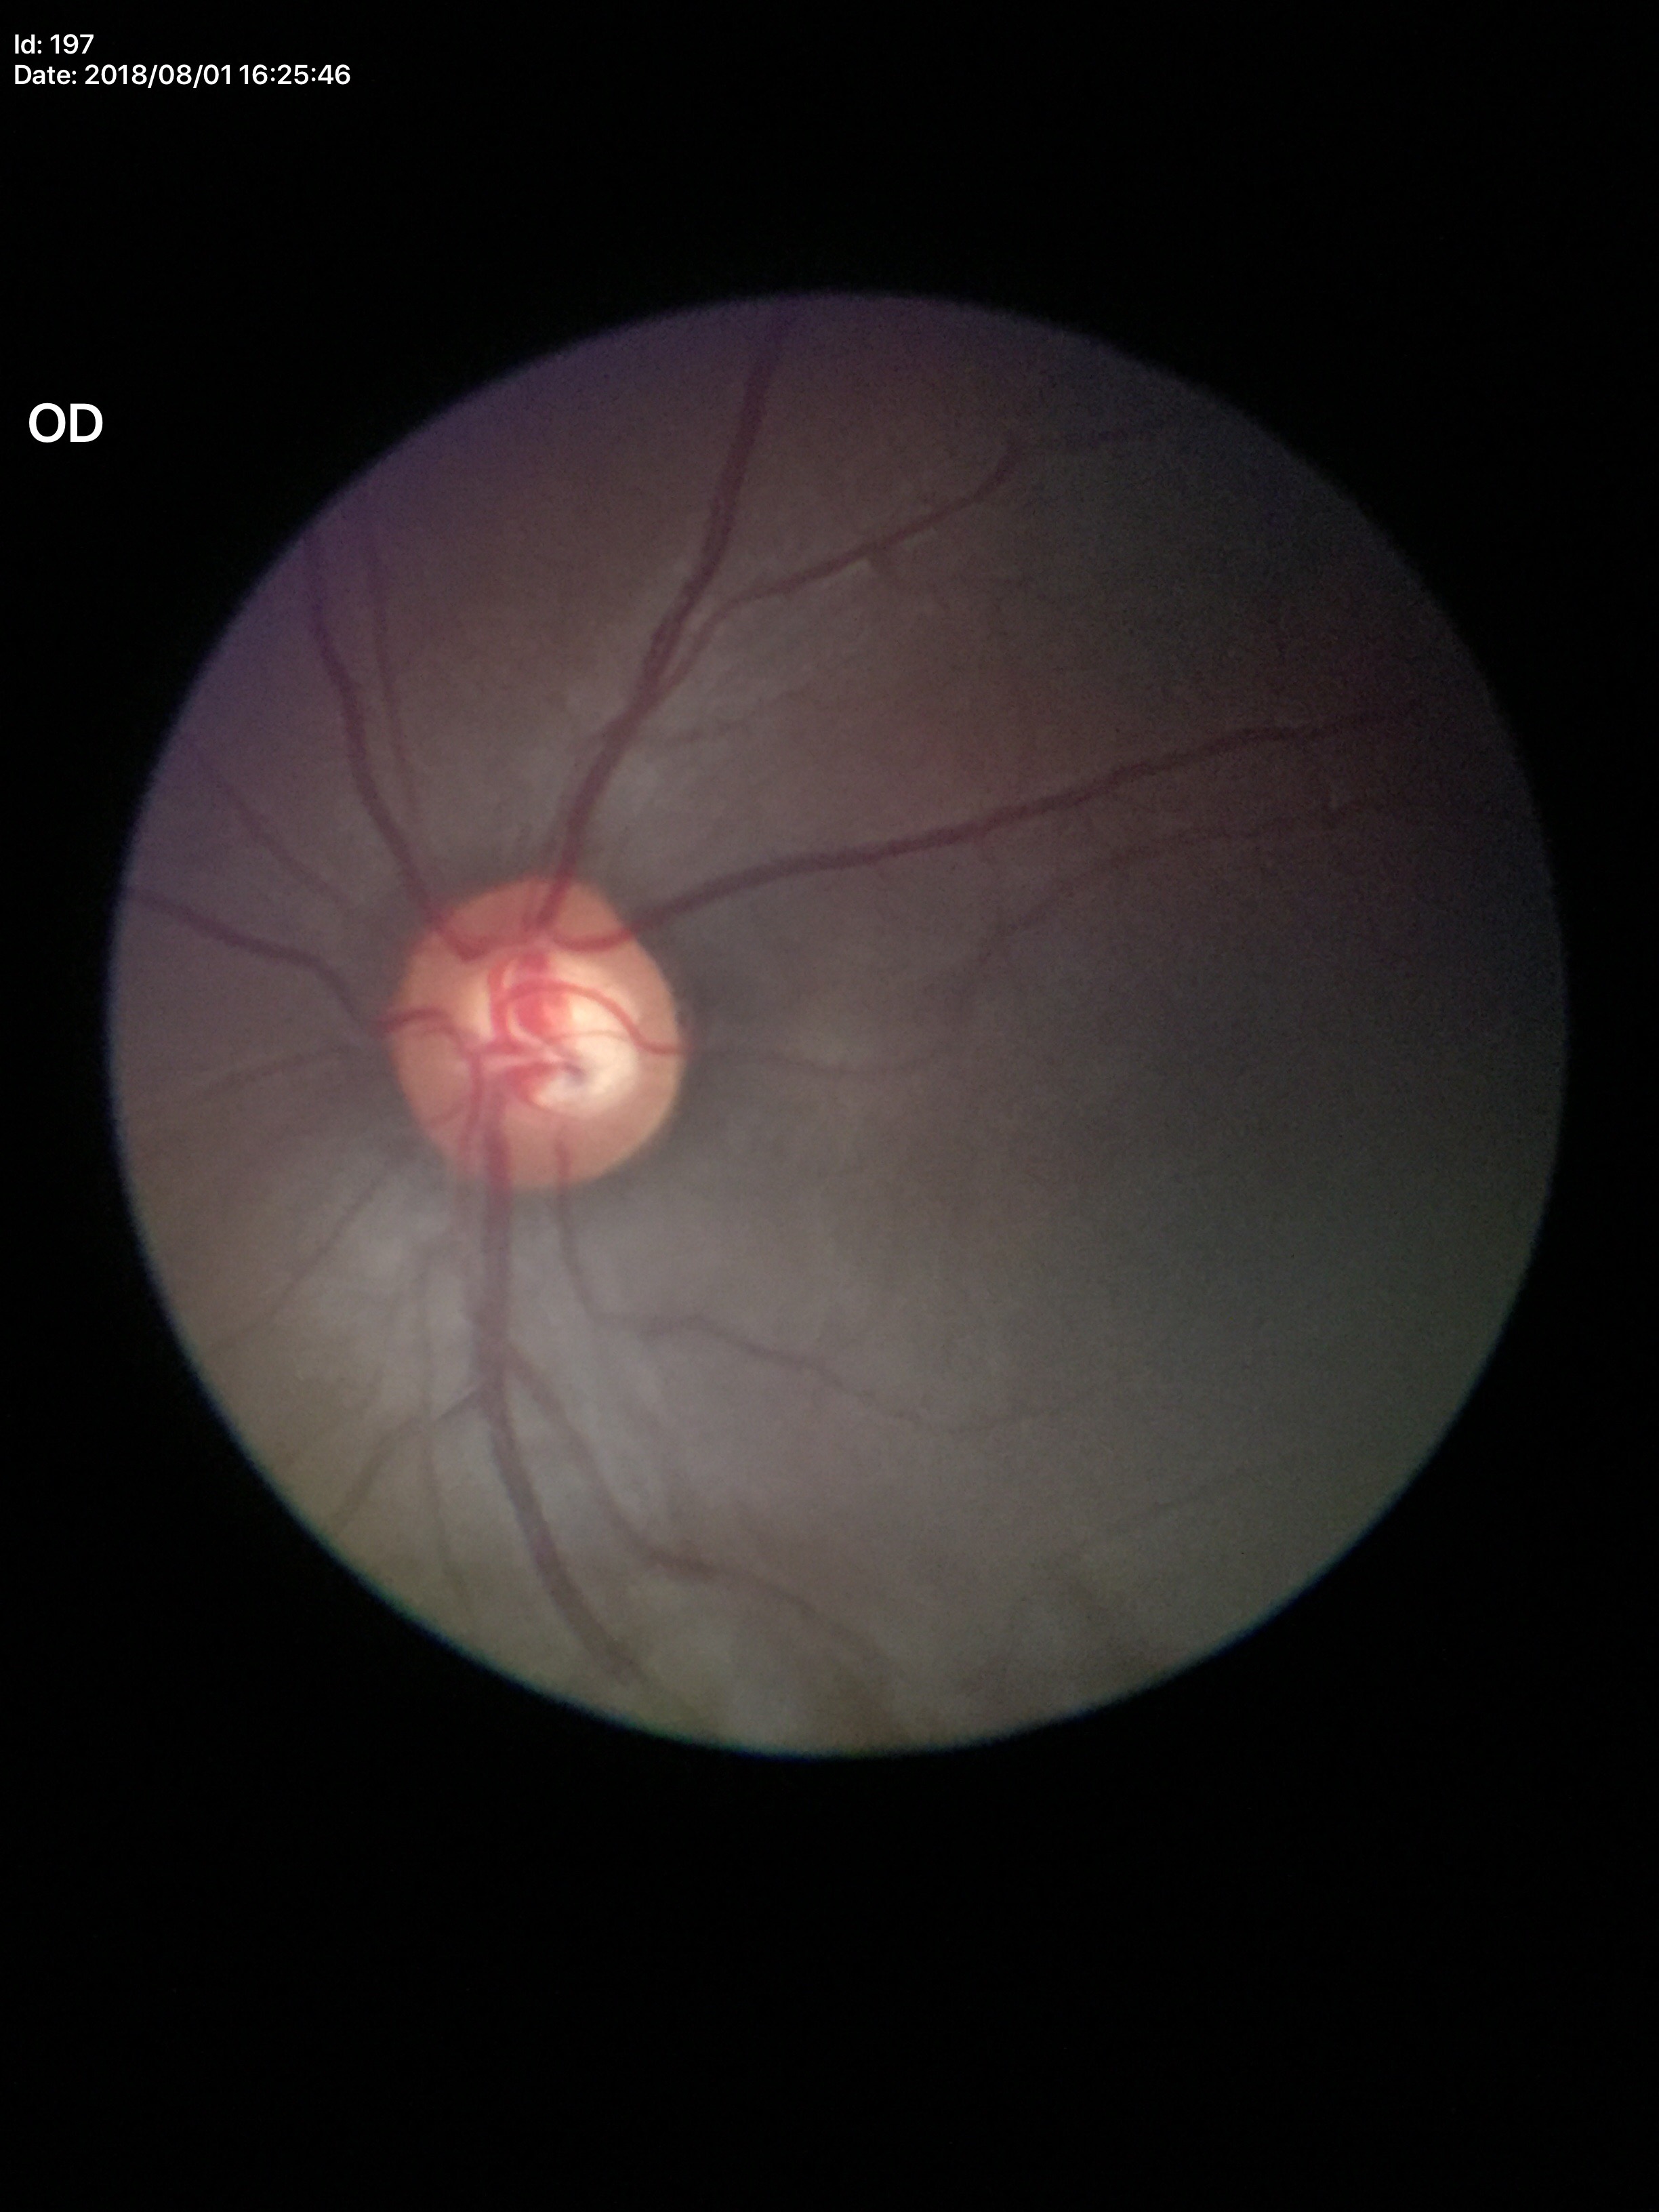 Concerning for glaucoma. Vertical cup-disc ratio (VCDR): 0.62. Area C/D ratio (ACDR) is 0.41.